2089x1764px — 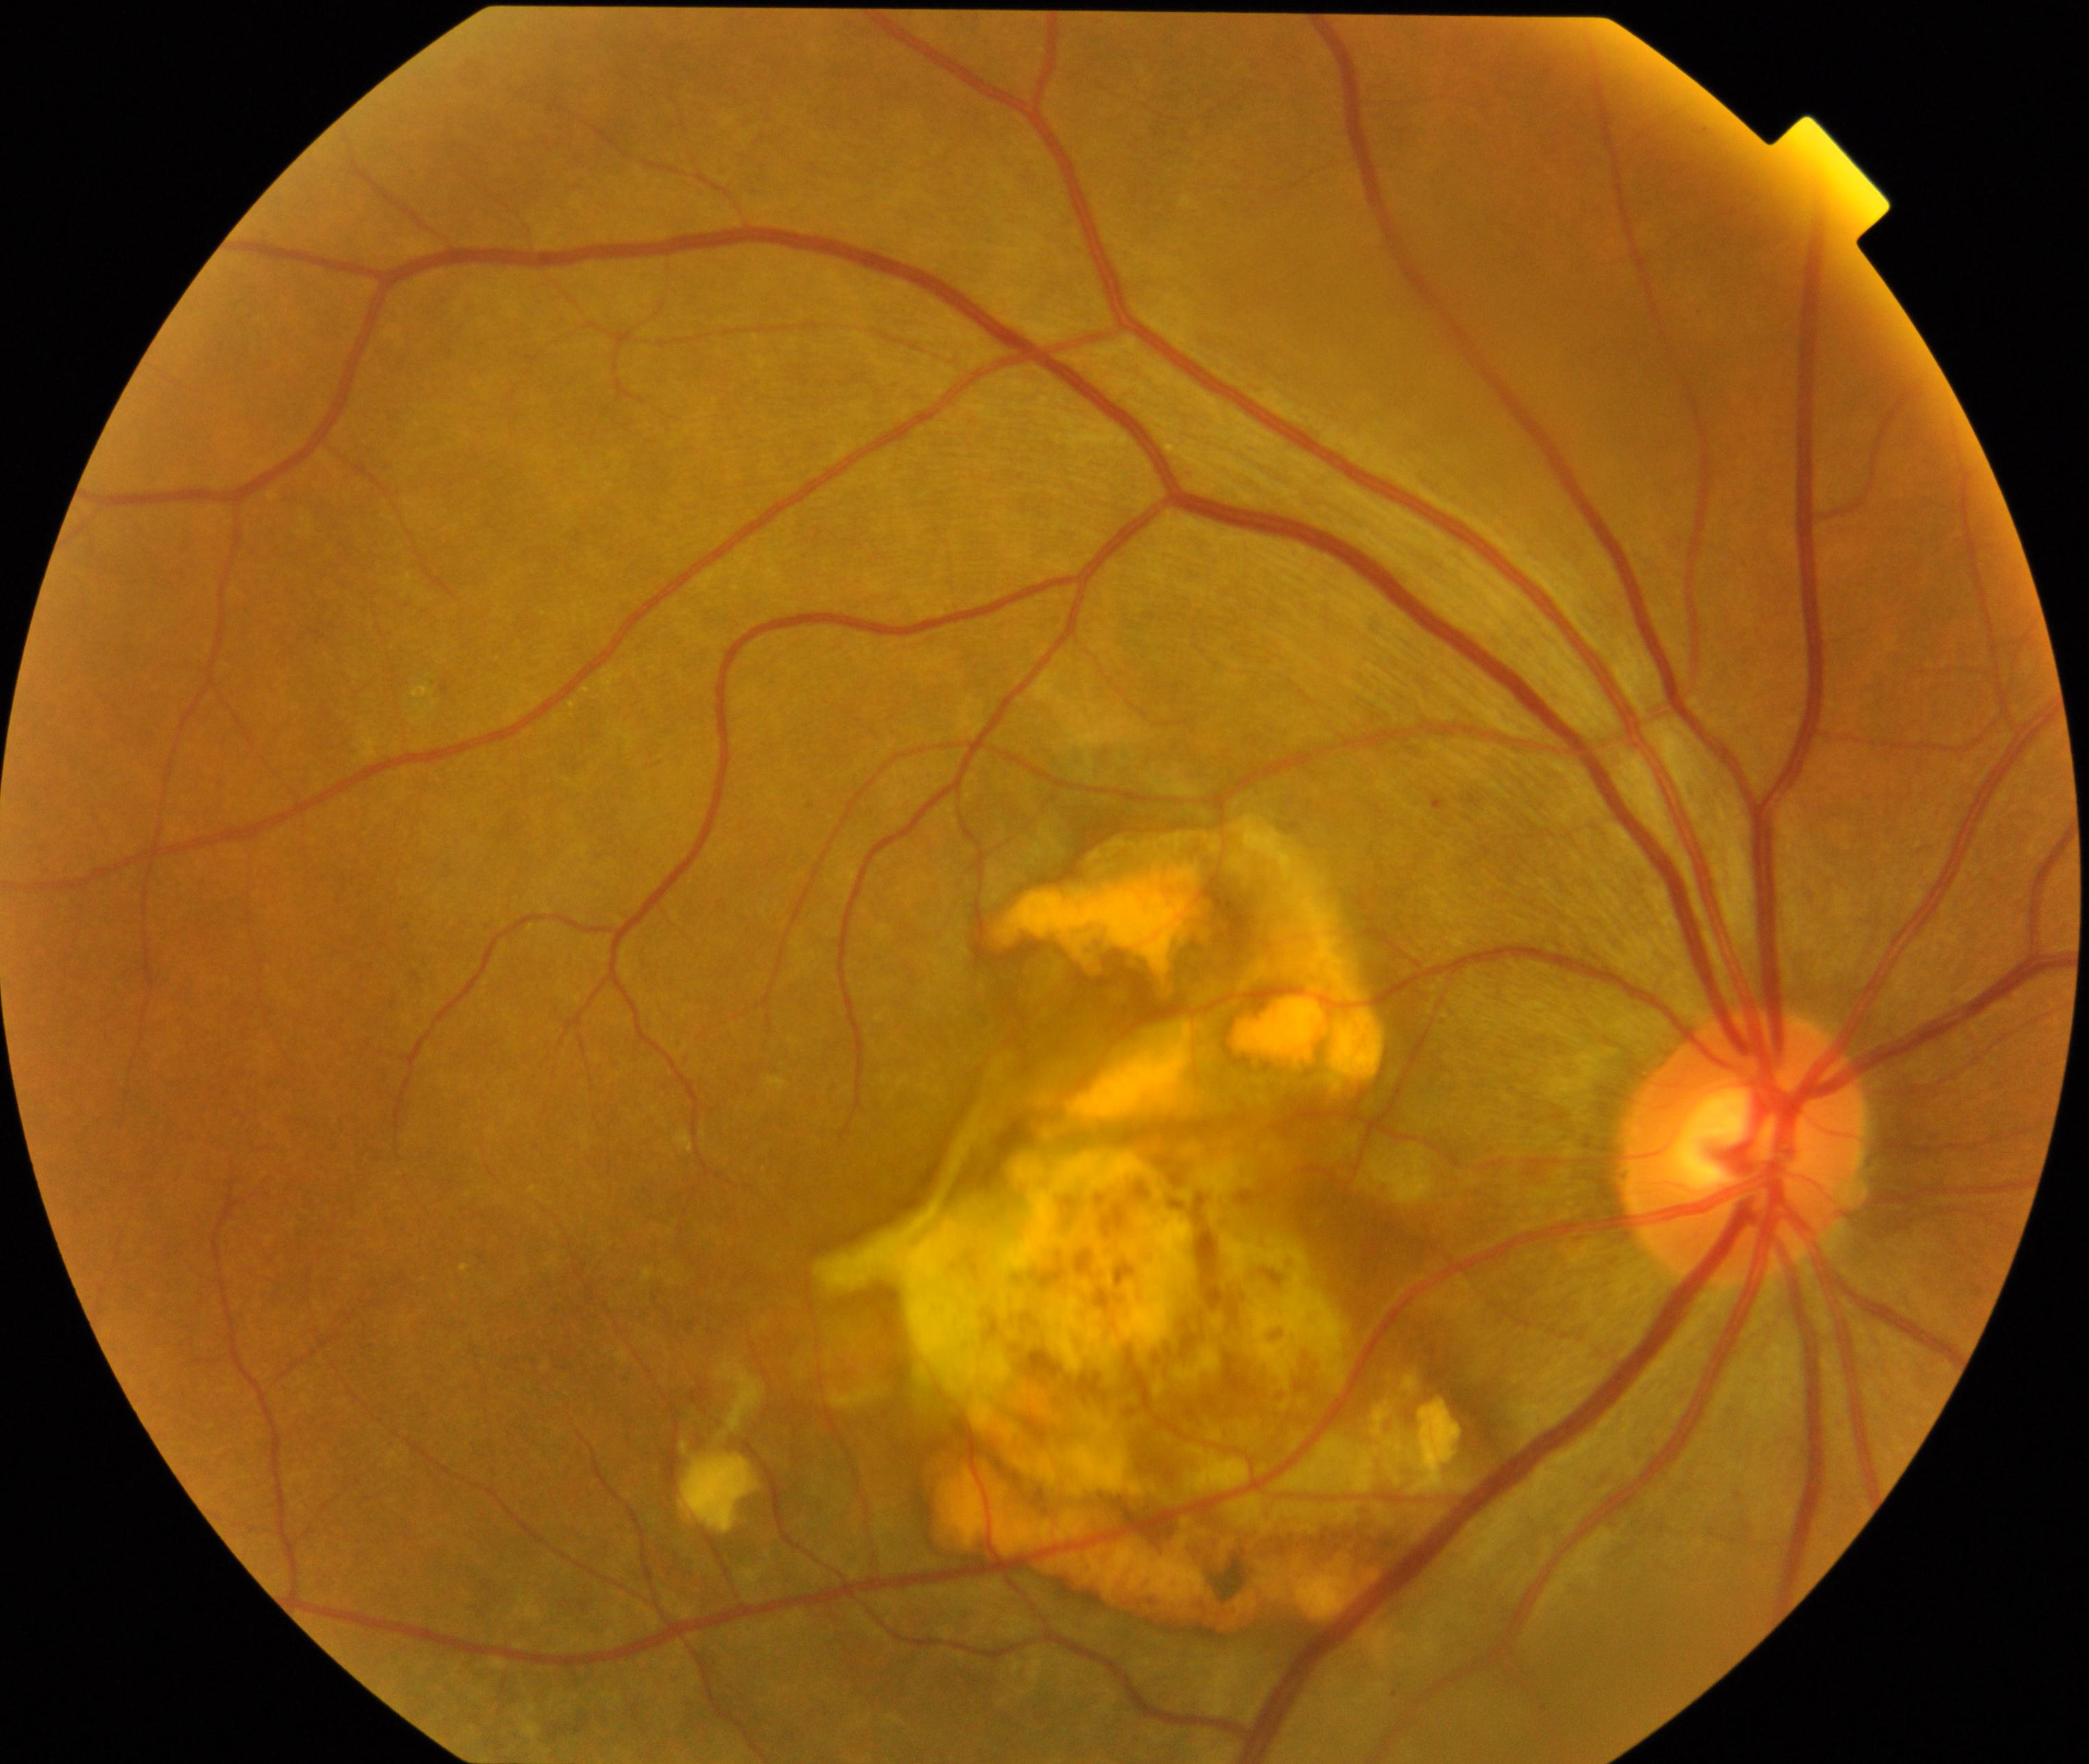 Diagnosis: maculopathy.